Color fundus image, 1659 by 2212 pixels: 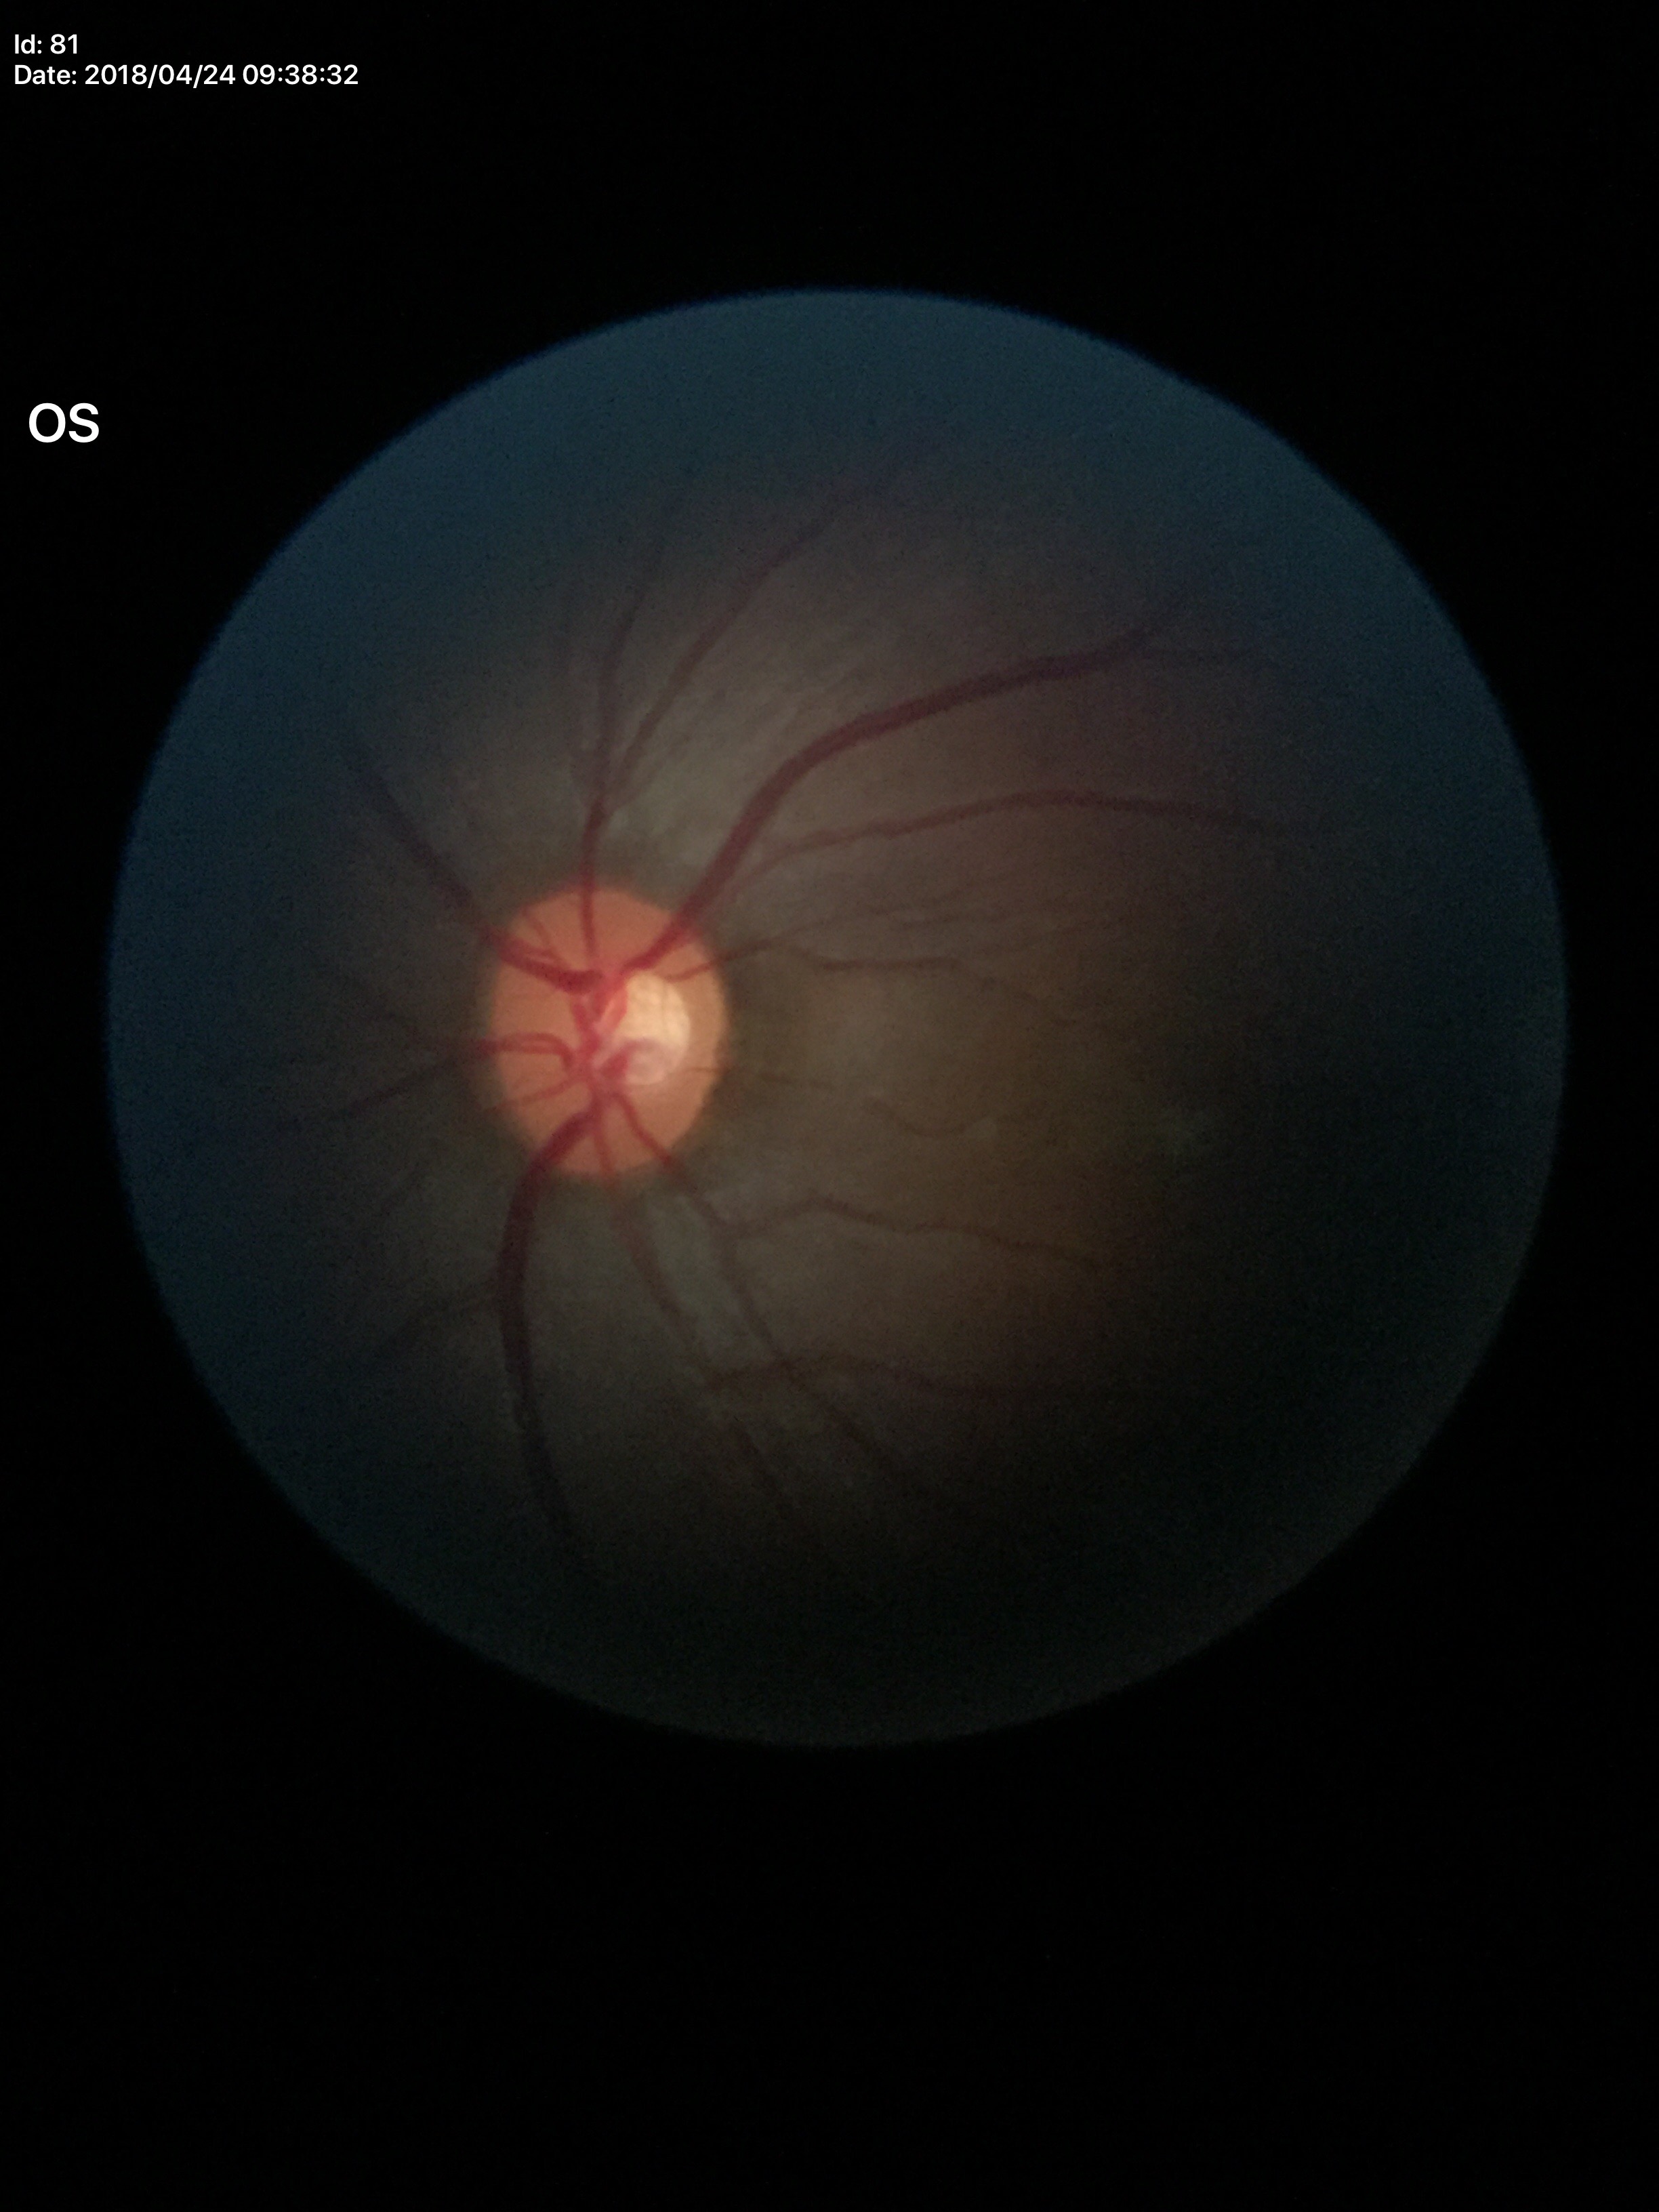 Glaucoma assessment: not suspect. Vertical CDR (VCDR) is 0.47.